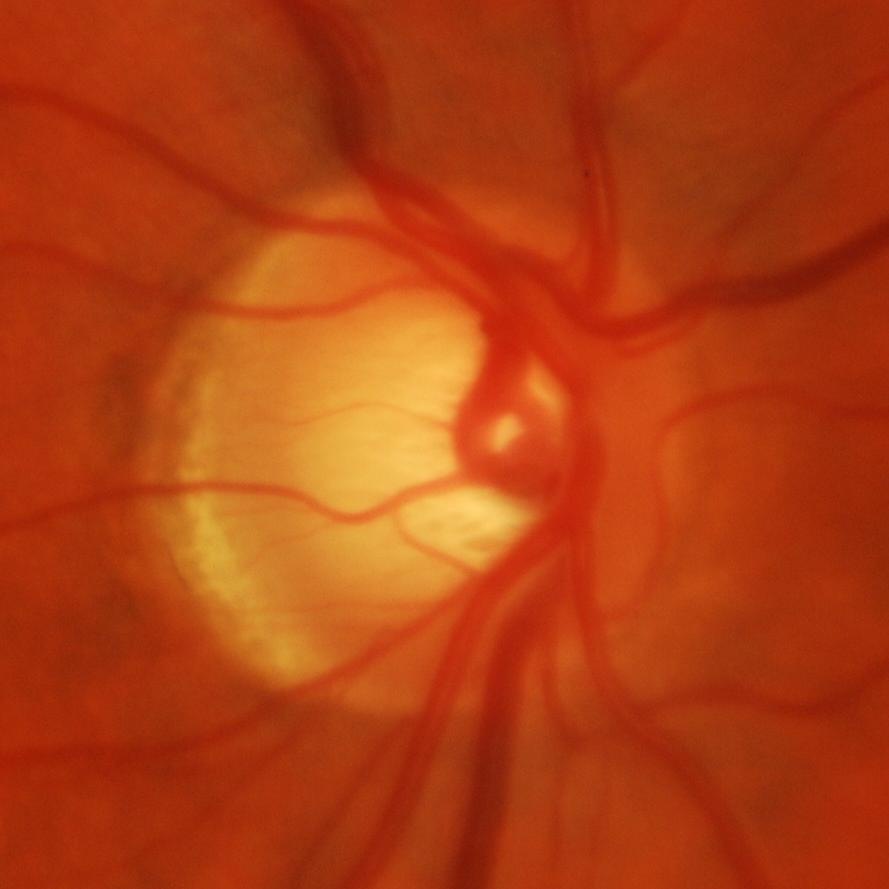 Finding = evidence of glaucoma.